Color fundus photograph; 1659x2212px:
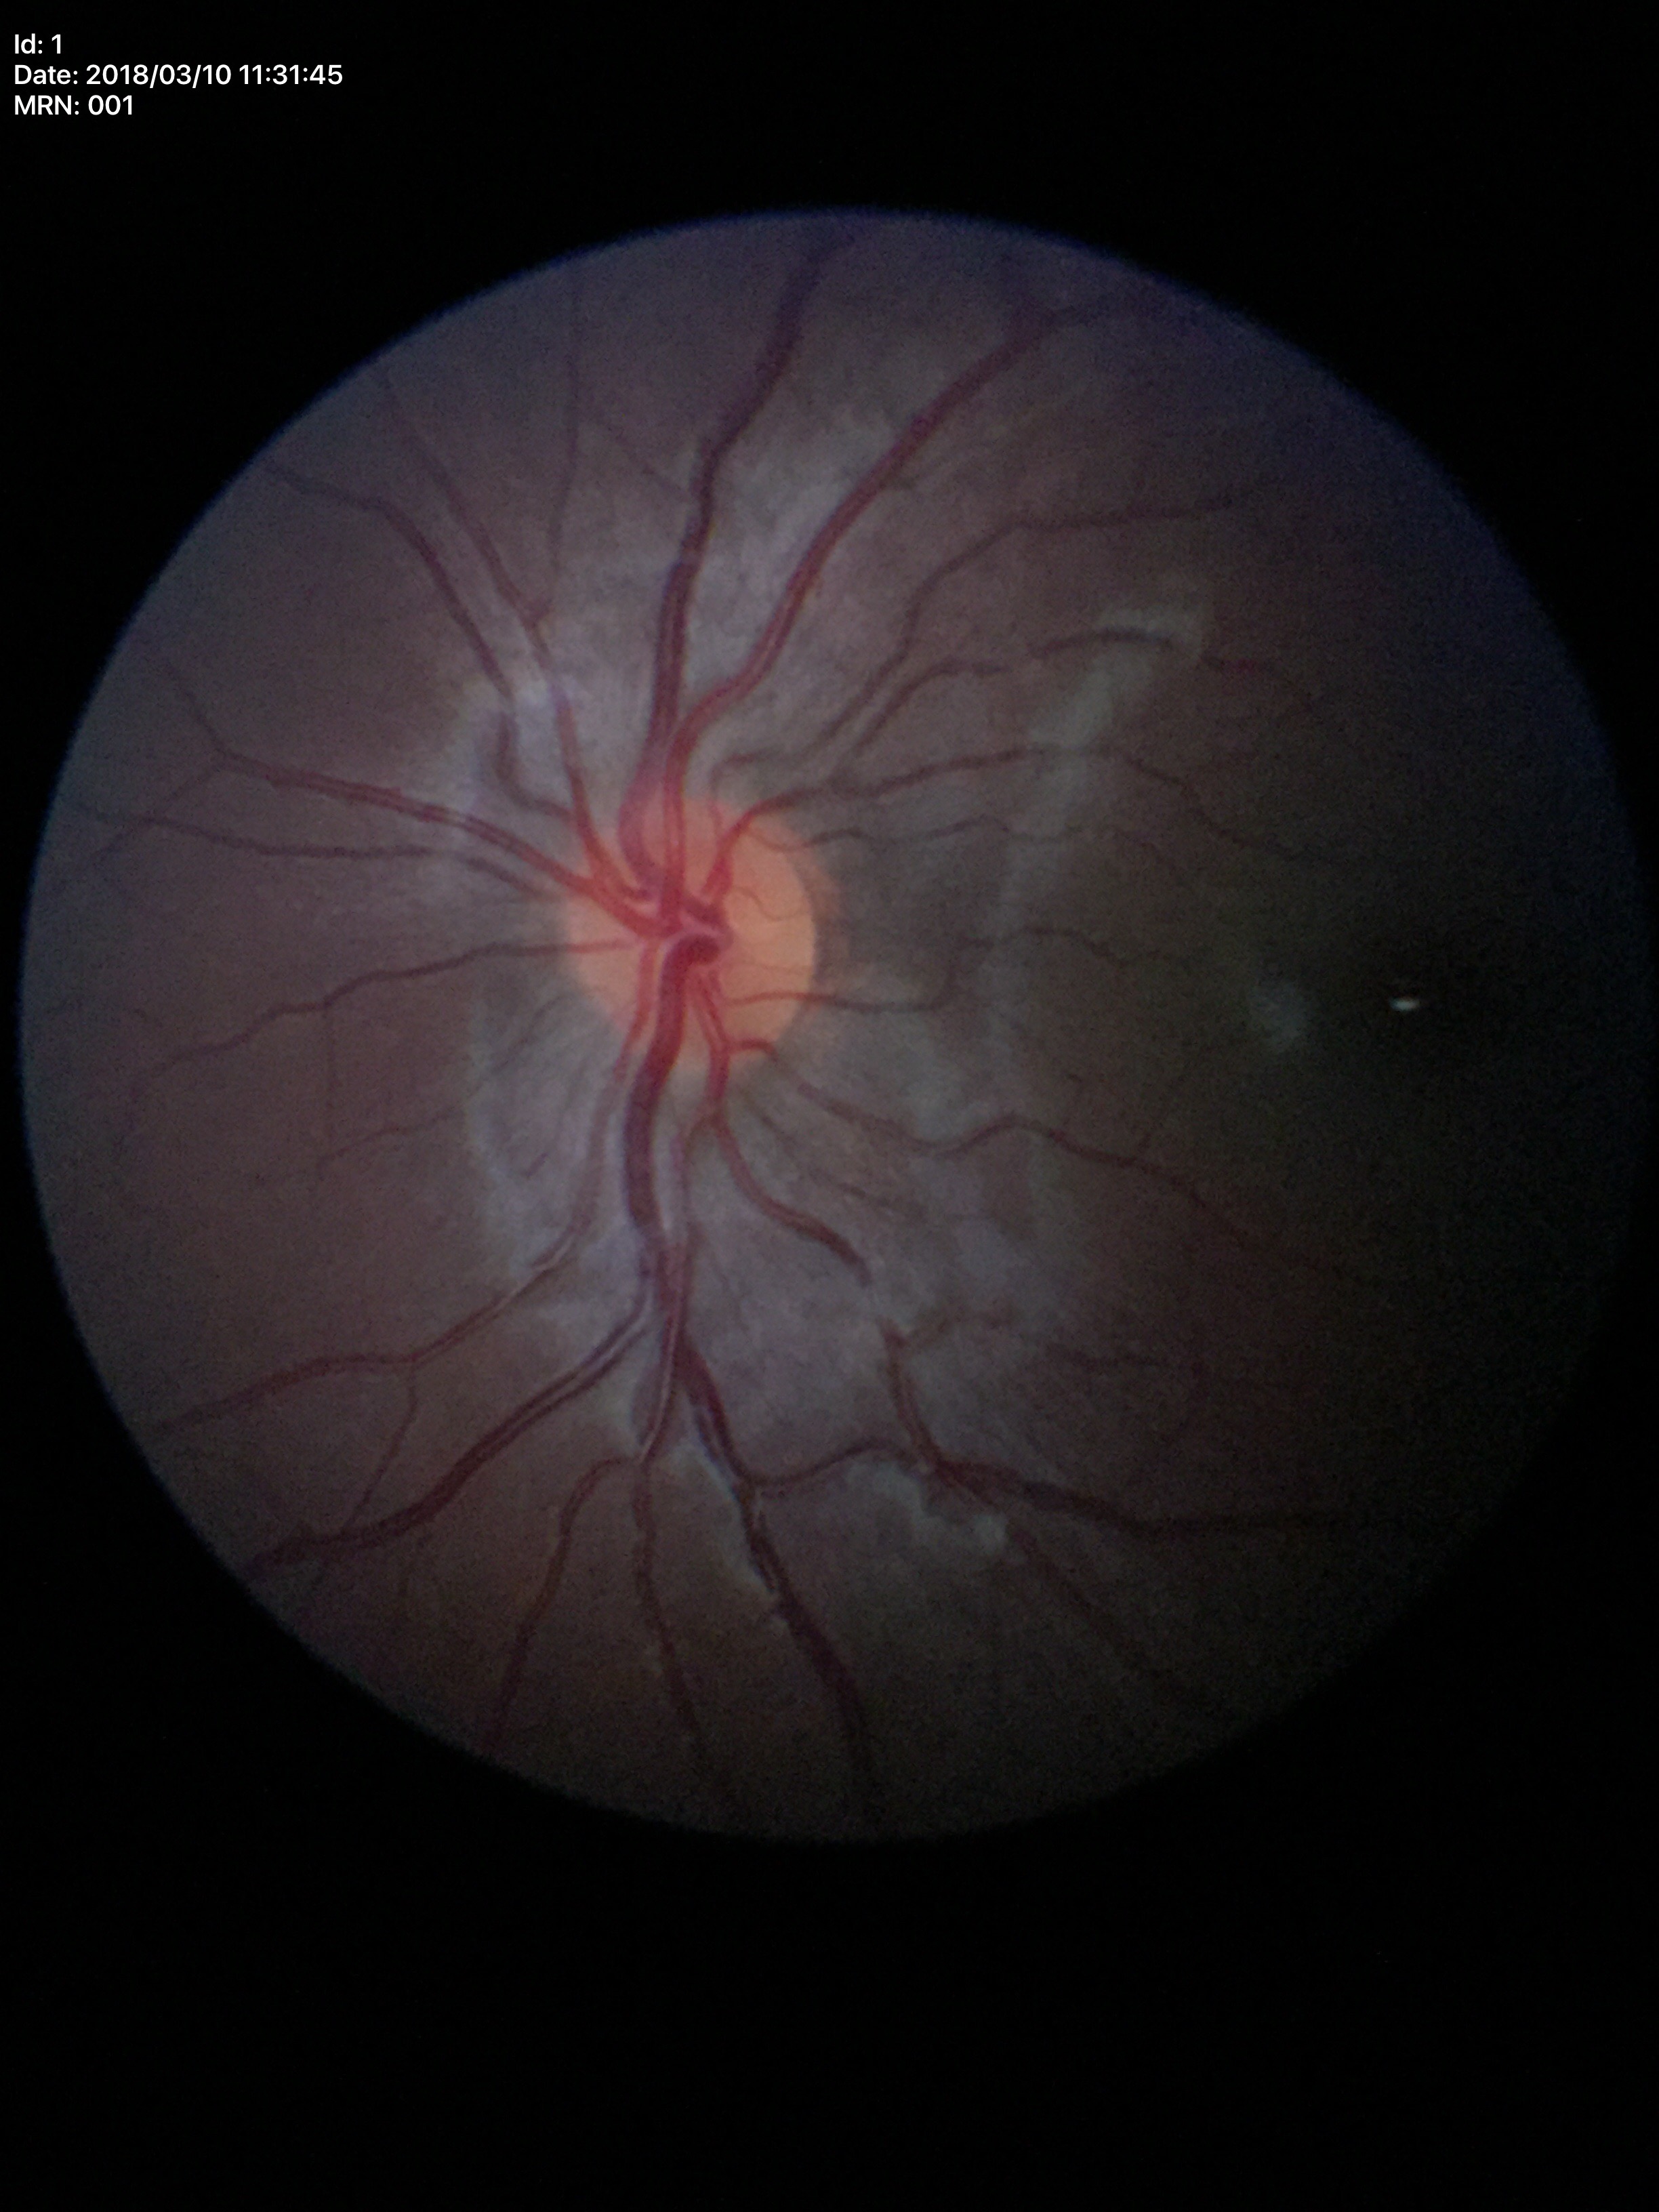
Glaucoma decision: no suspicious findings (5/5 ophthalmologists in agreement). VCDR is 0.42.